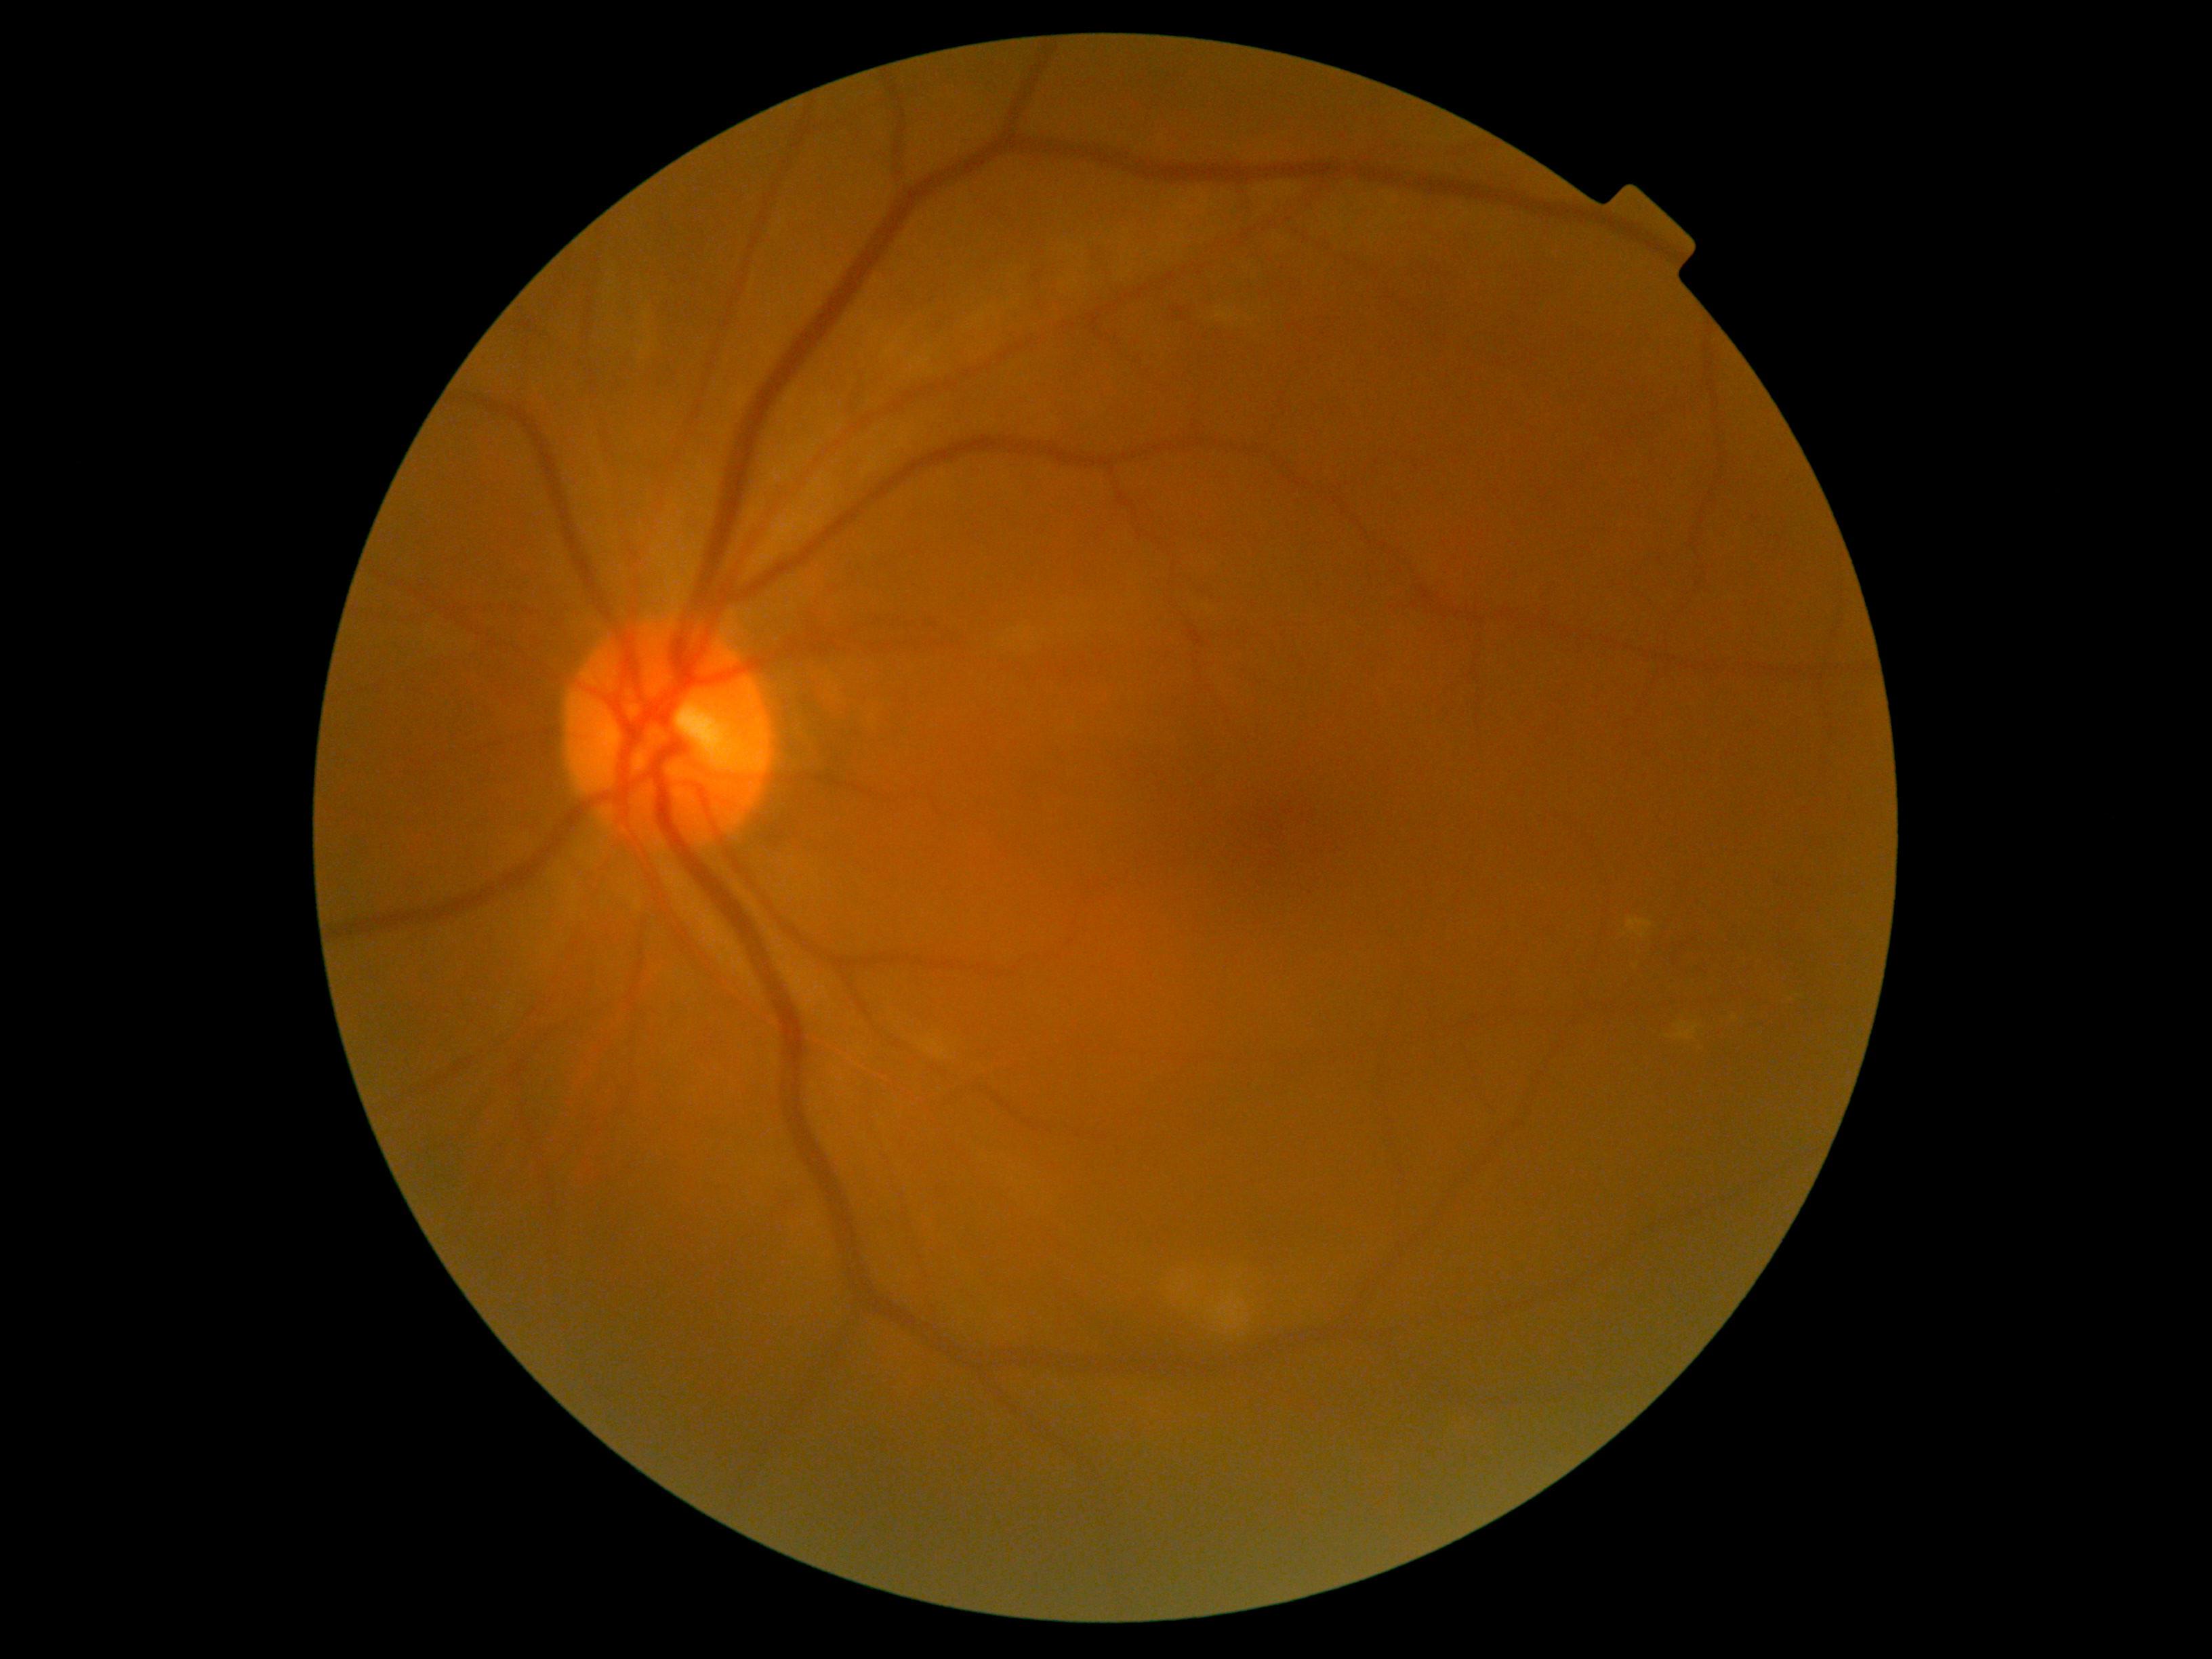

{
  "dr_grade": "2/4 — more than just microaneurysms but less than severe NPDR"
}